Mydriatic (tropicamide and phenylephrine)
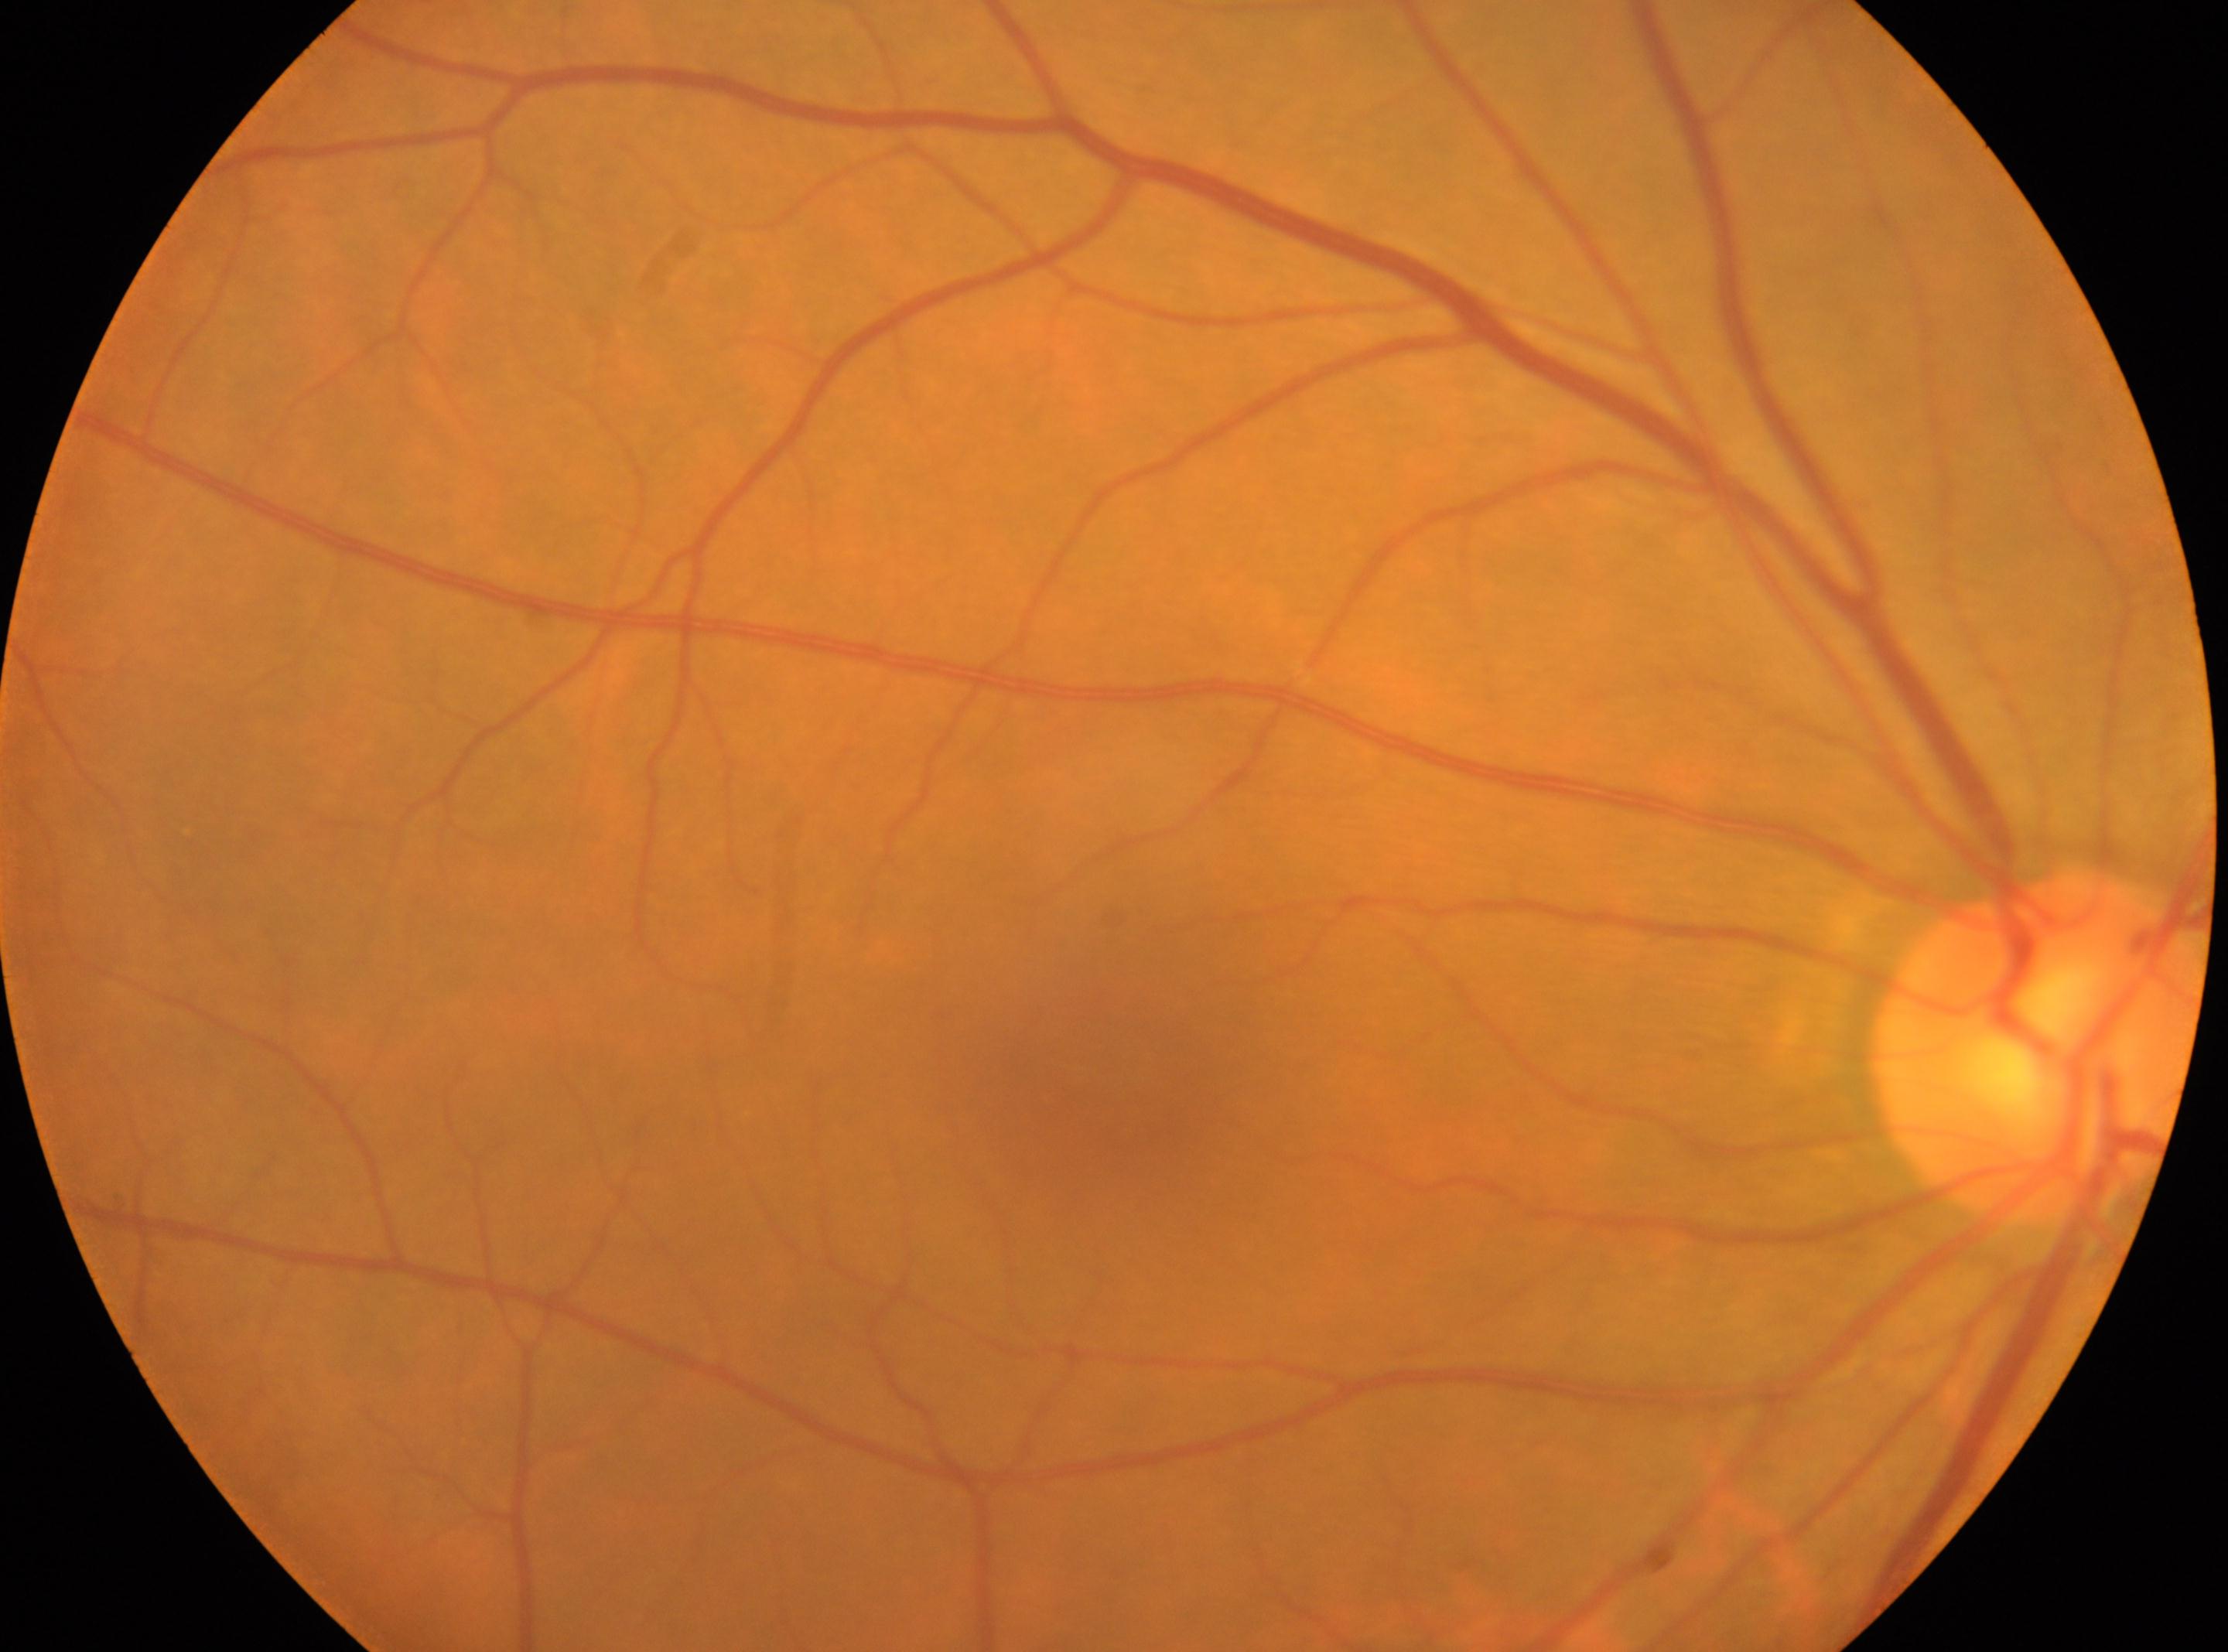 DR impression = No DR findings; laterality = right eye; DR grade = 0; optic disc center = (x: 2038, y: 1048); fovea centralis = (x: 1112, y: 1069).